1932x1932:
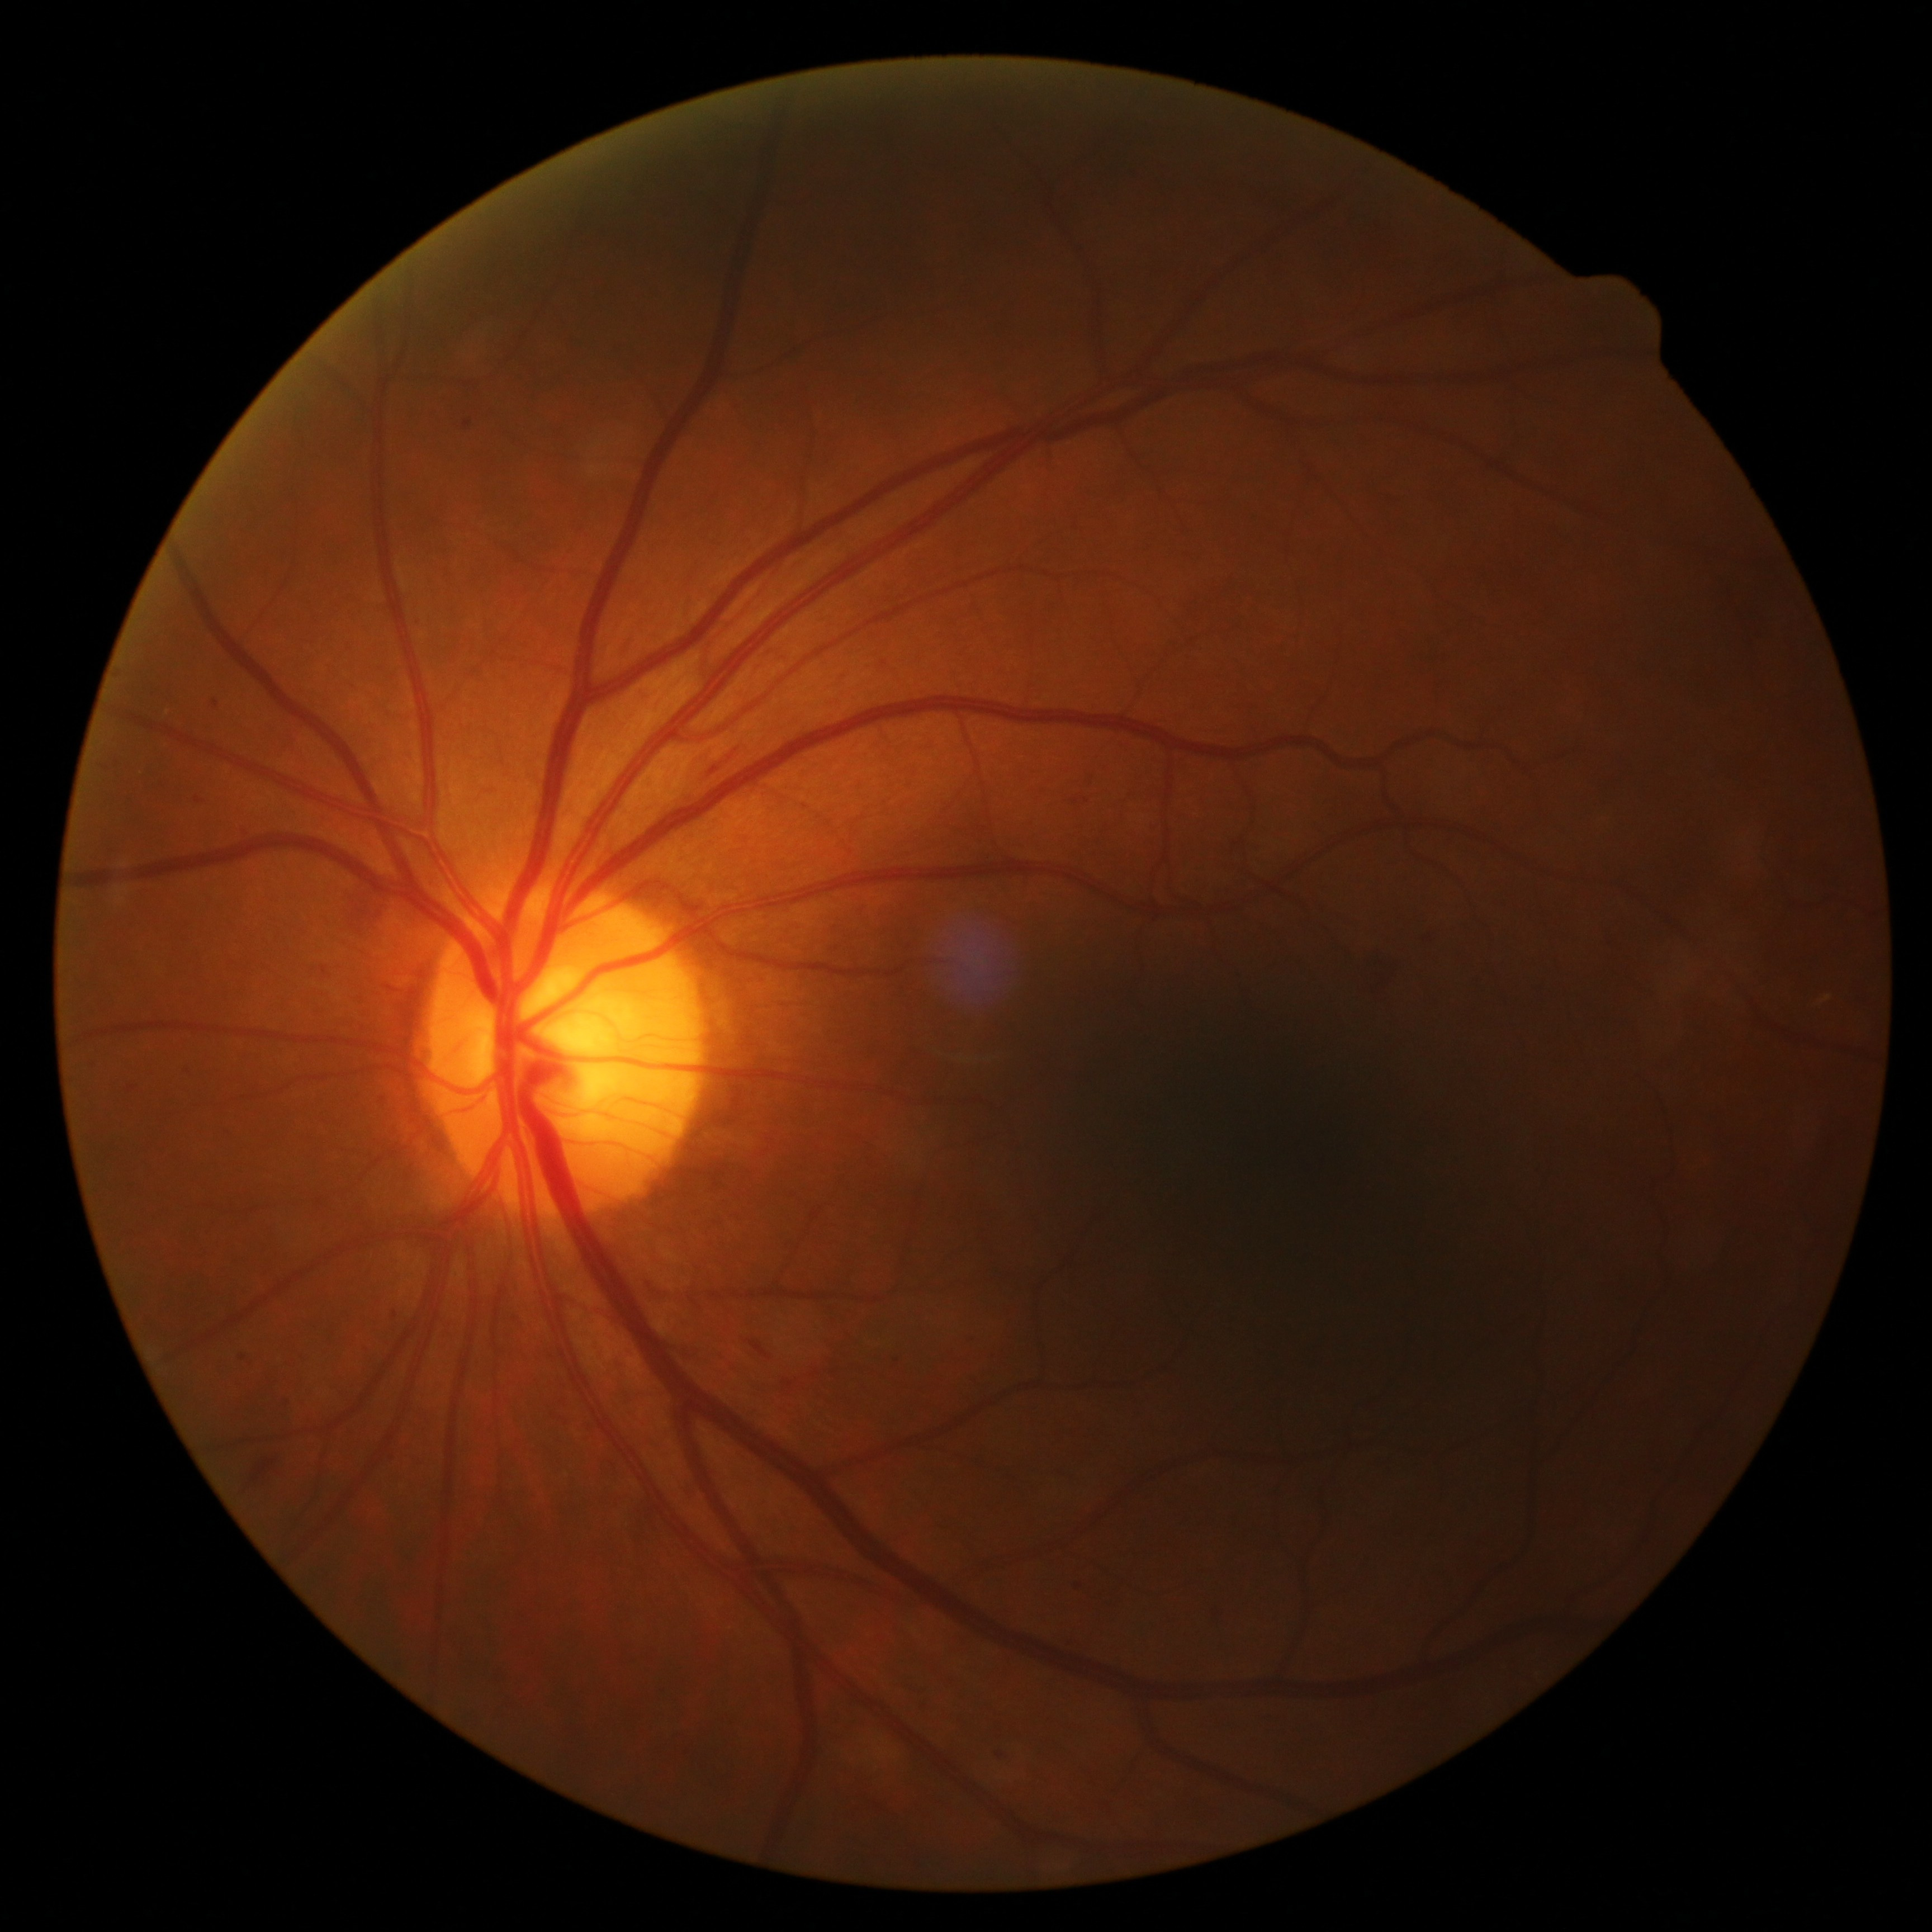
dr_grade: 2 — more than just microaneurysms but less than severe NPDR
dr_category: non-proliferative diabetic retinopathy